Infant wide-field fundus photograph · 130° field of view (Clarity RetCam 3) · 640 x 480 pixels.
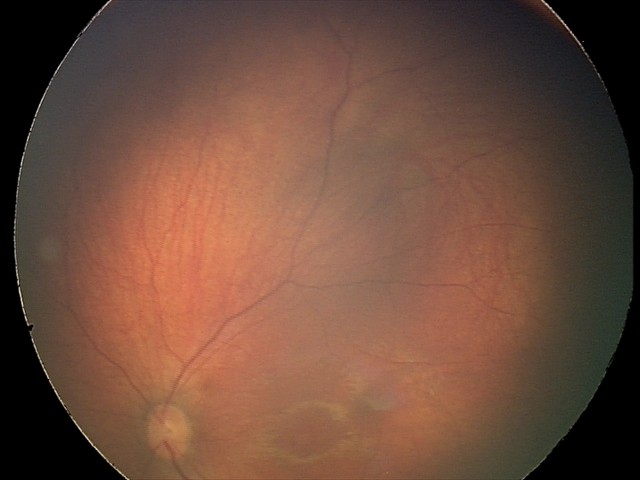 Diagnosis = retinal hemorrhages.